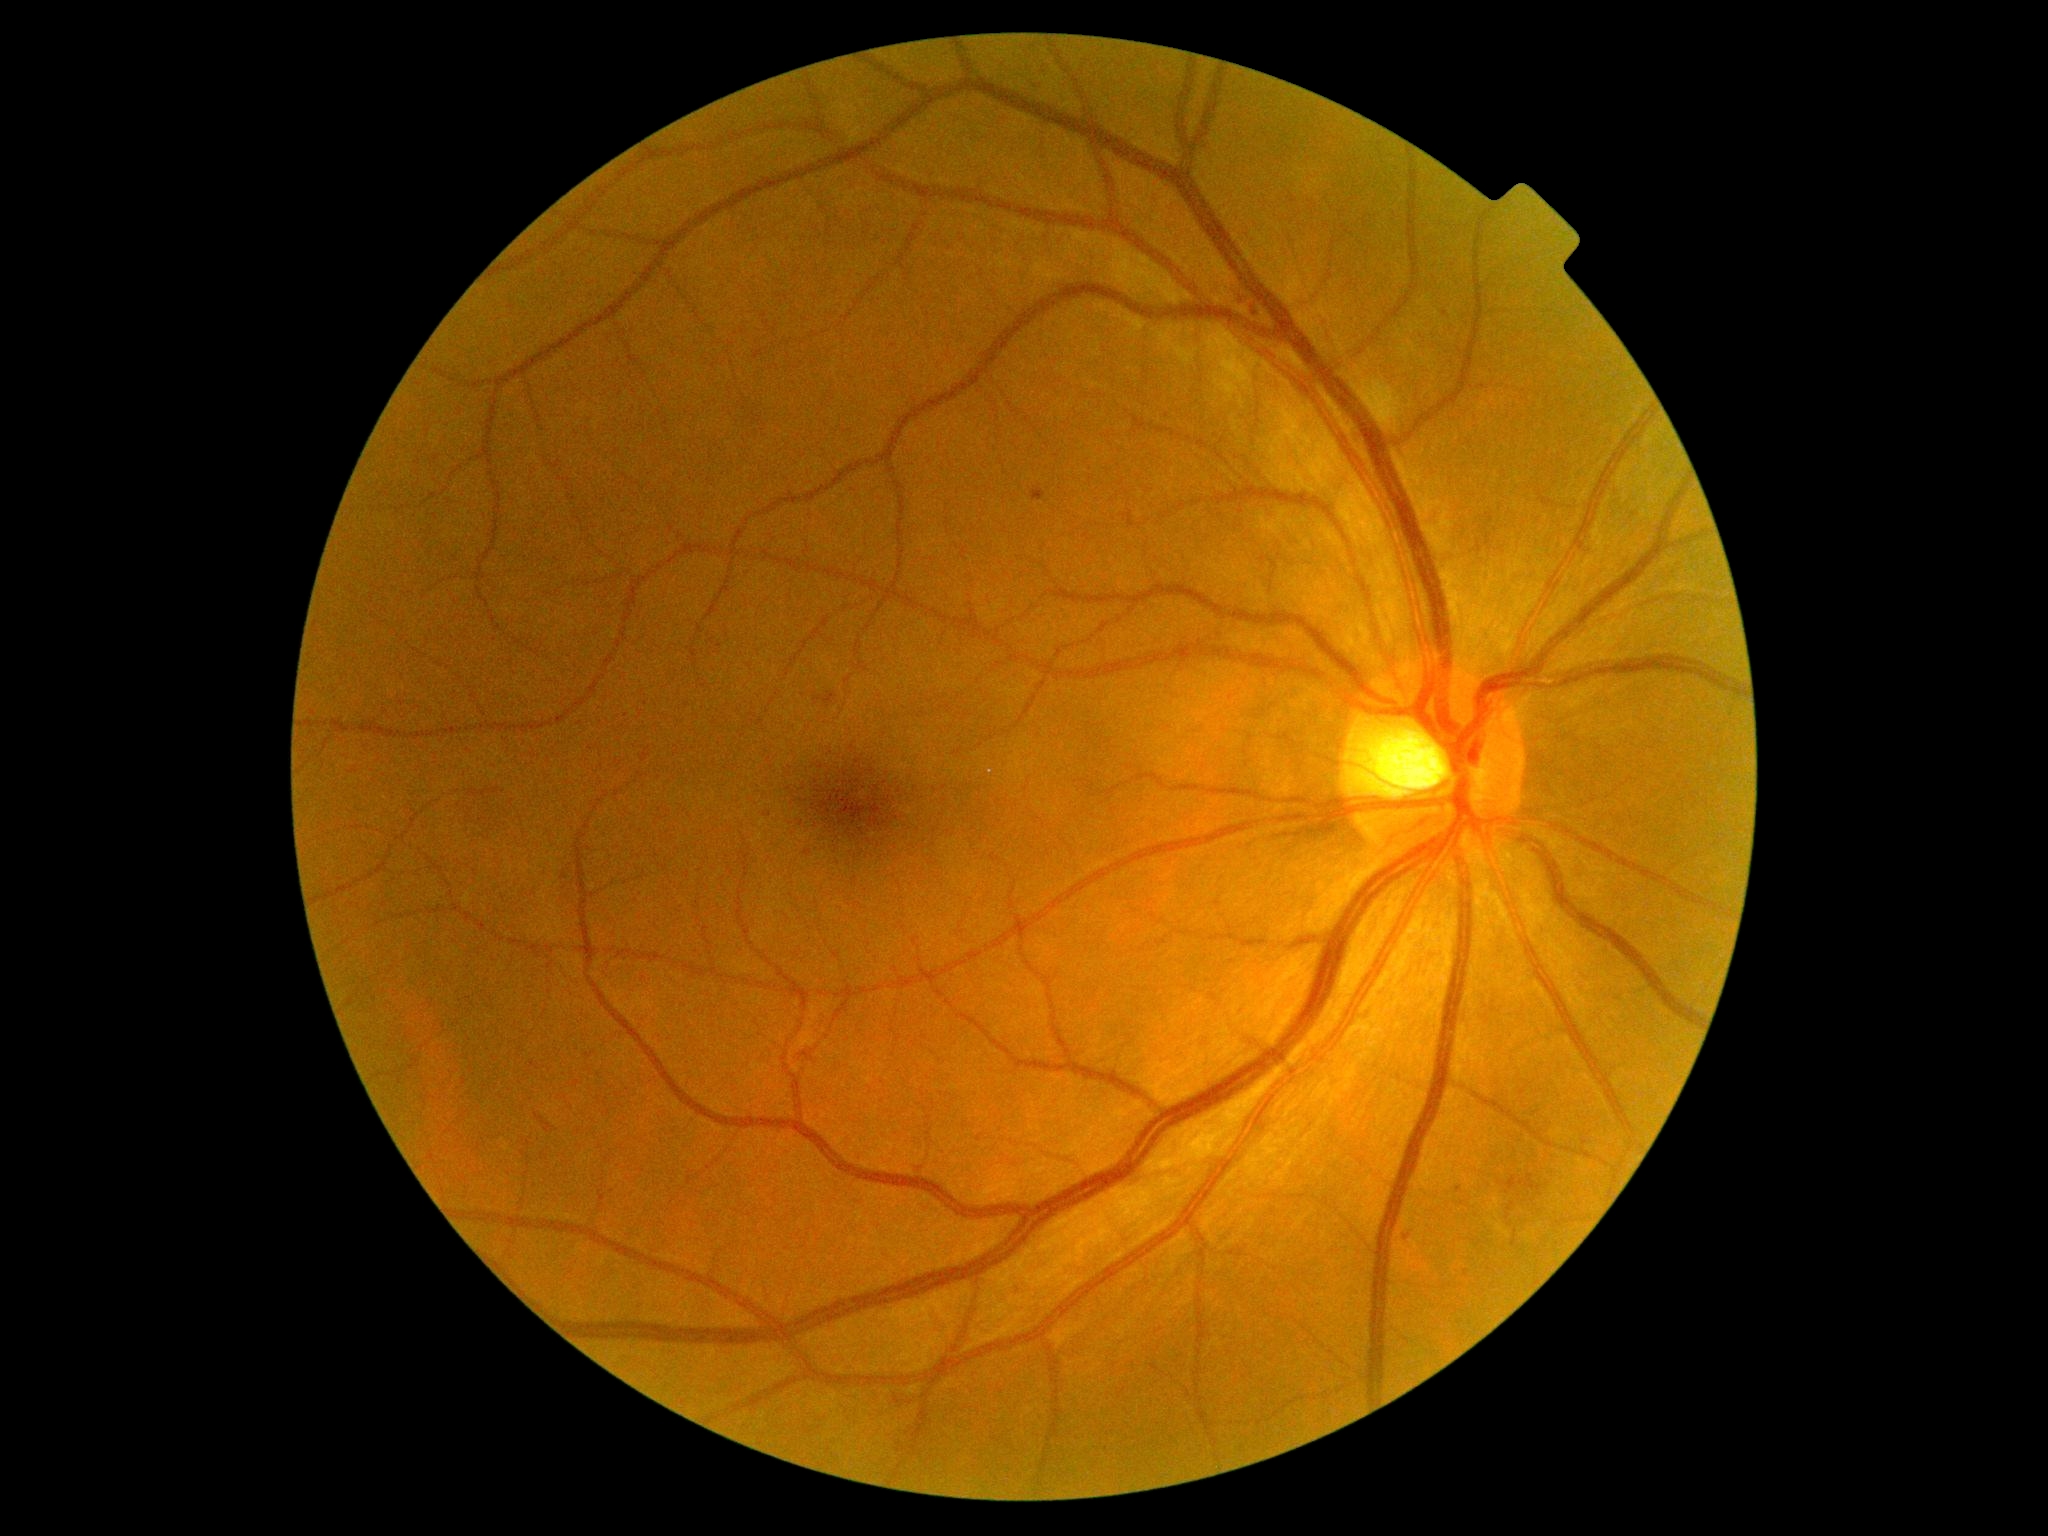 DR severity: moderate NPDR (grade 2). DR class: non-proliferative diabetic retinopathy.